Wide-field contact fundus photograph of an infant. Natus RetCam Envision, 130° FOV — 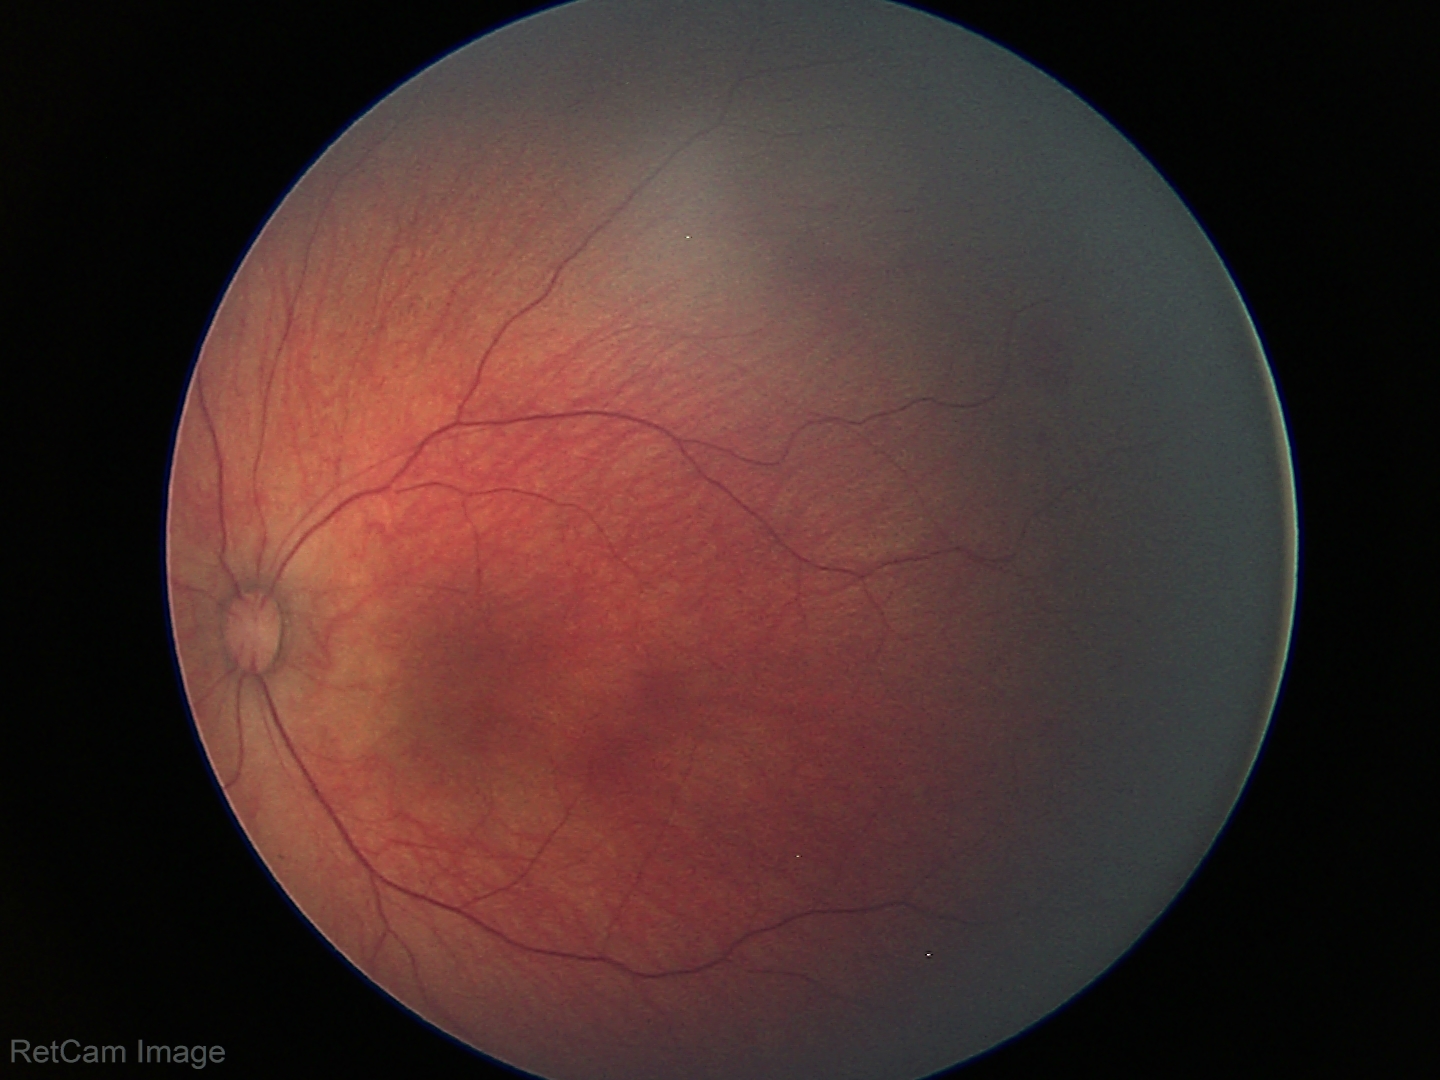
Examination diagnosed as retinal hemorrhages.